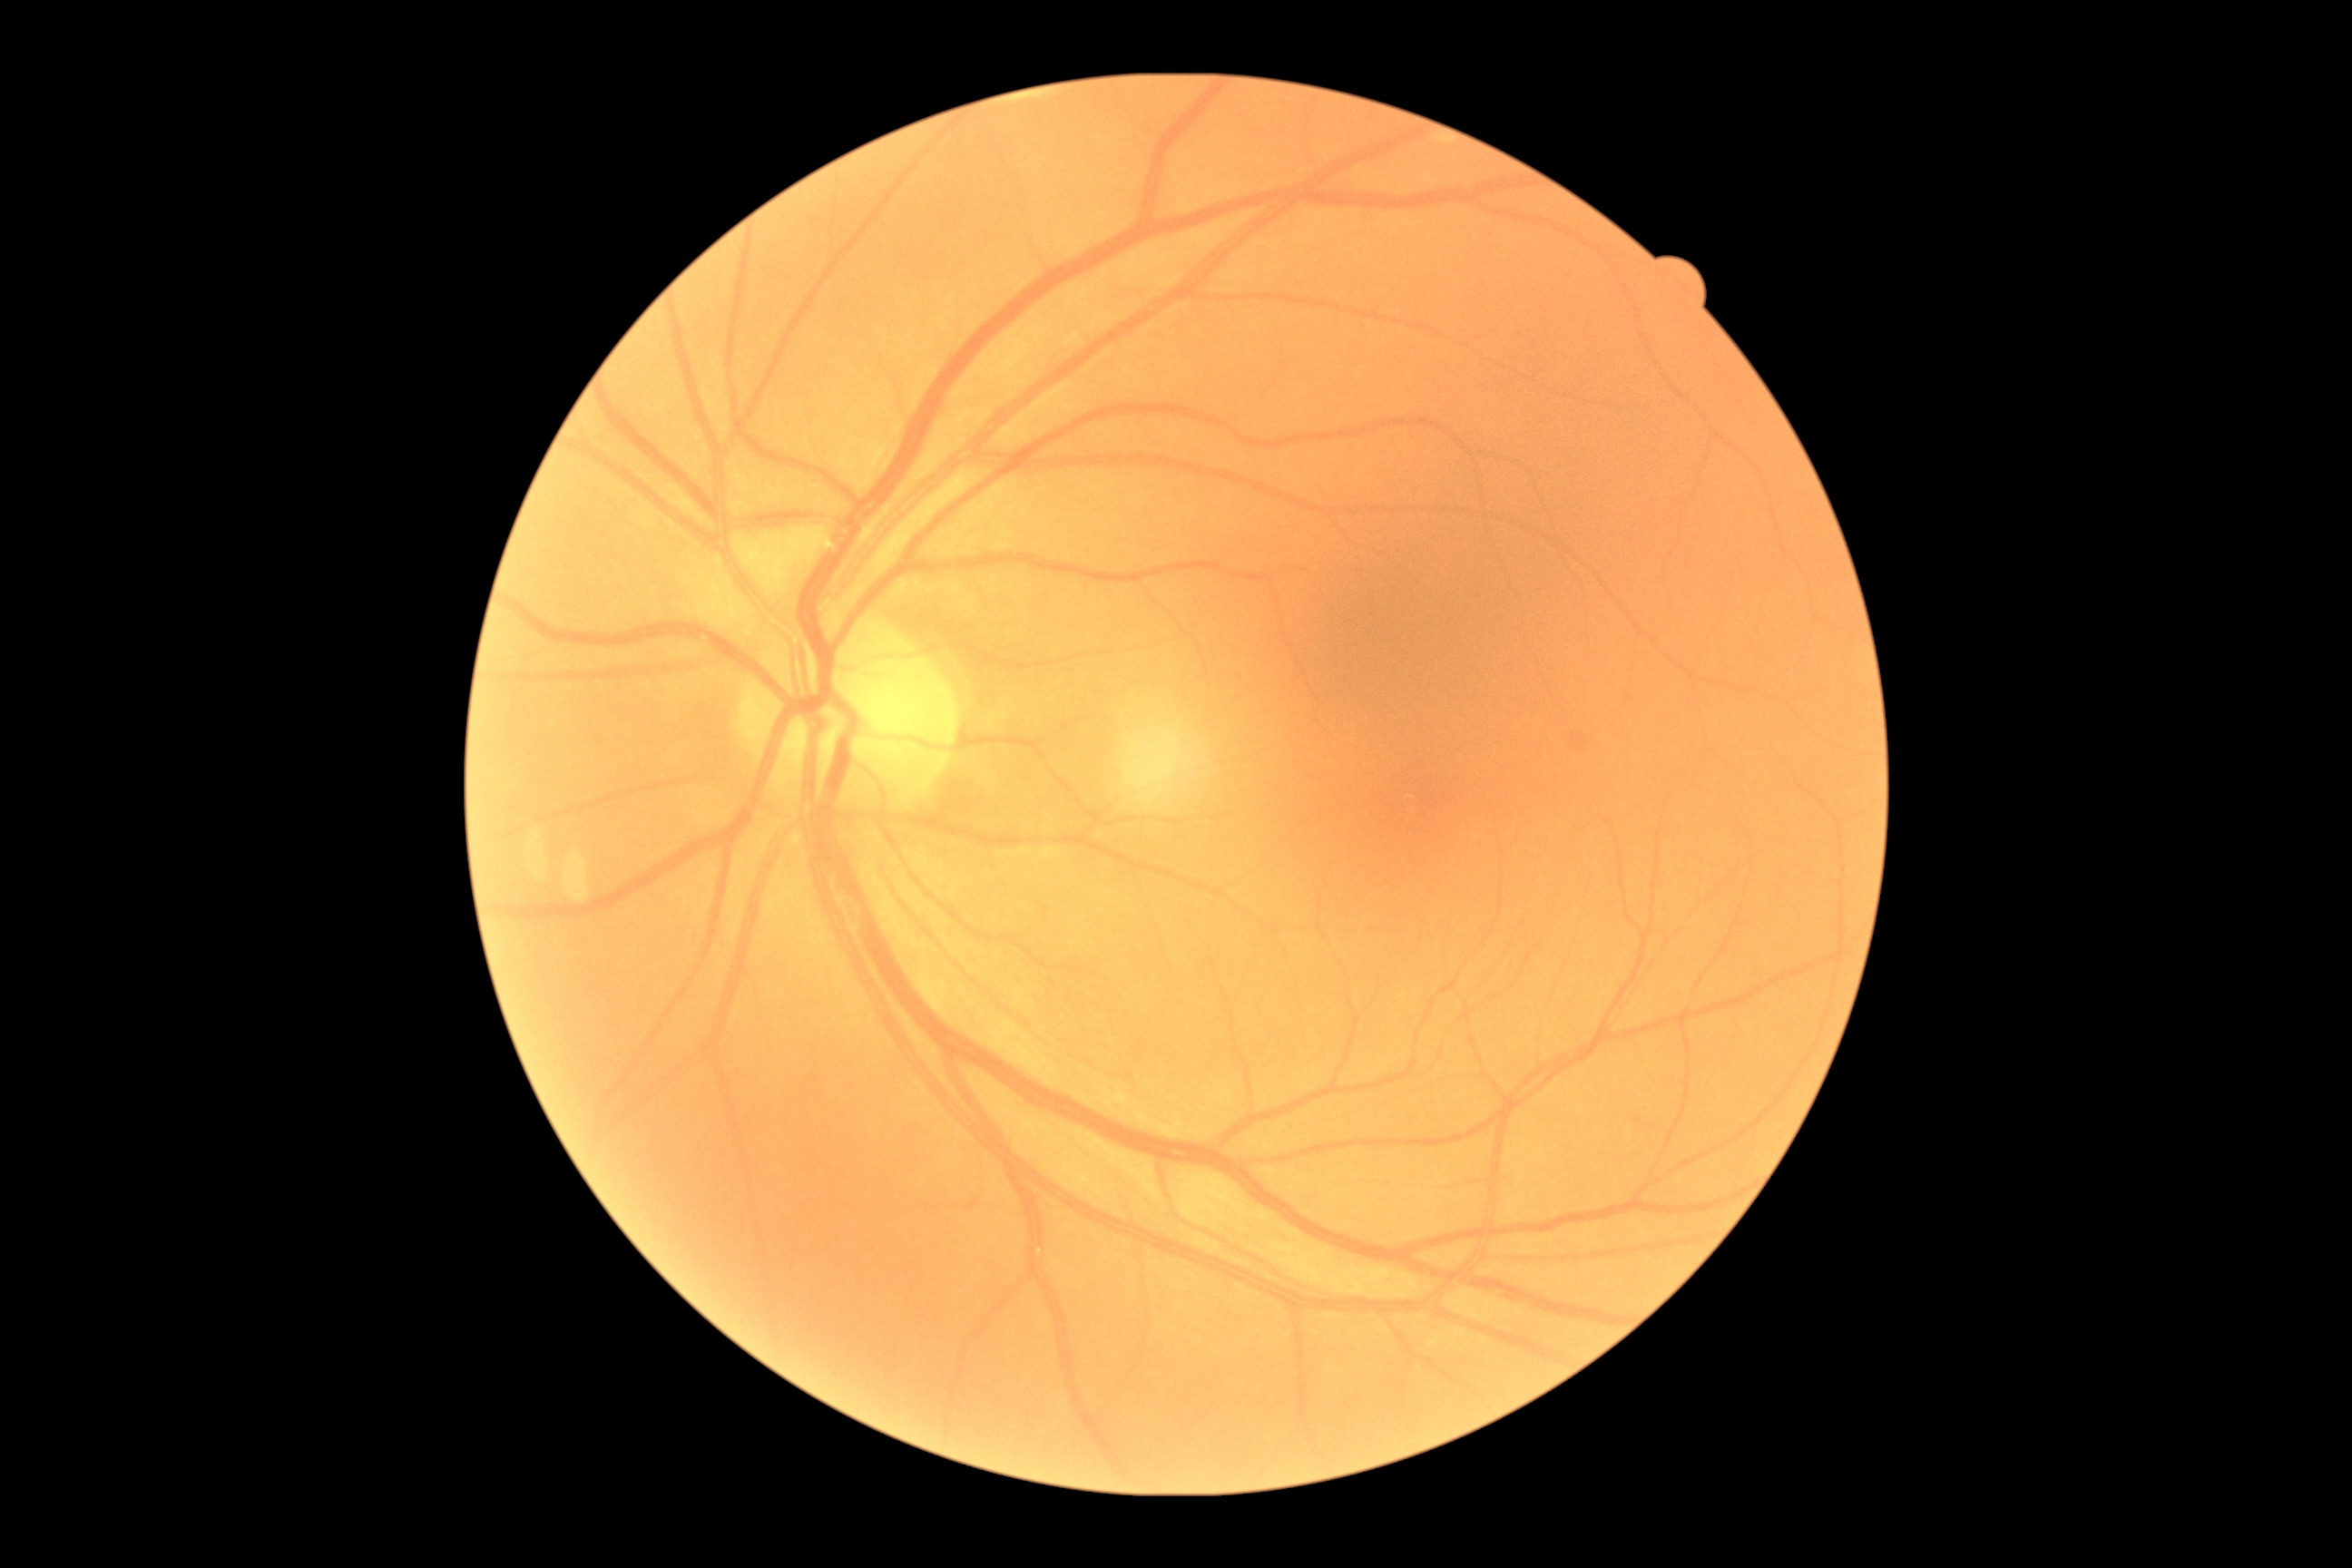

Diabetic retinopathy (DR) is grade 0 (no apparent retinopathy).